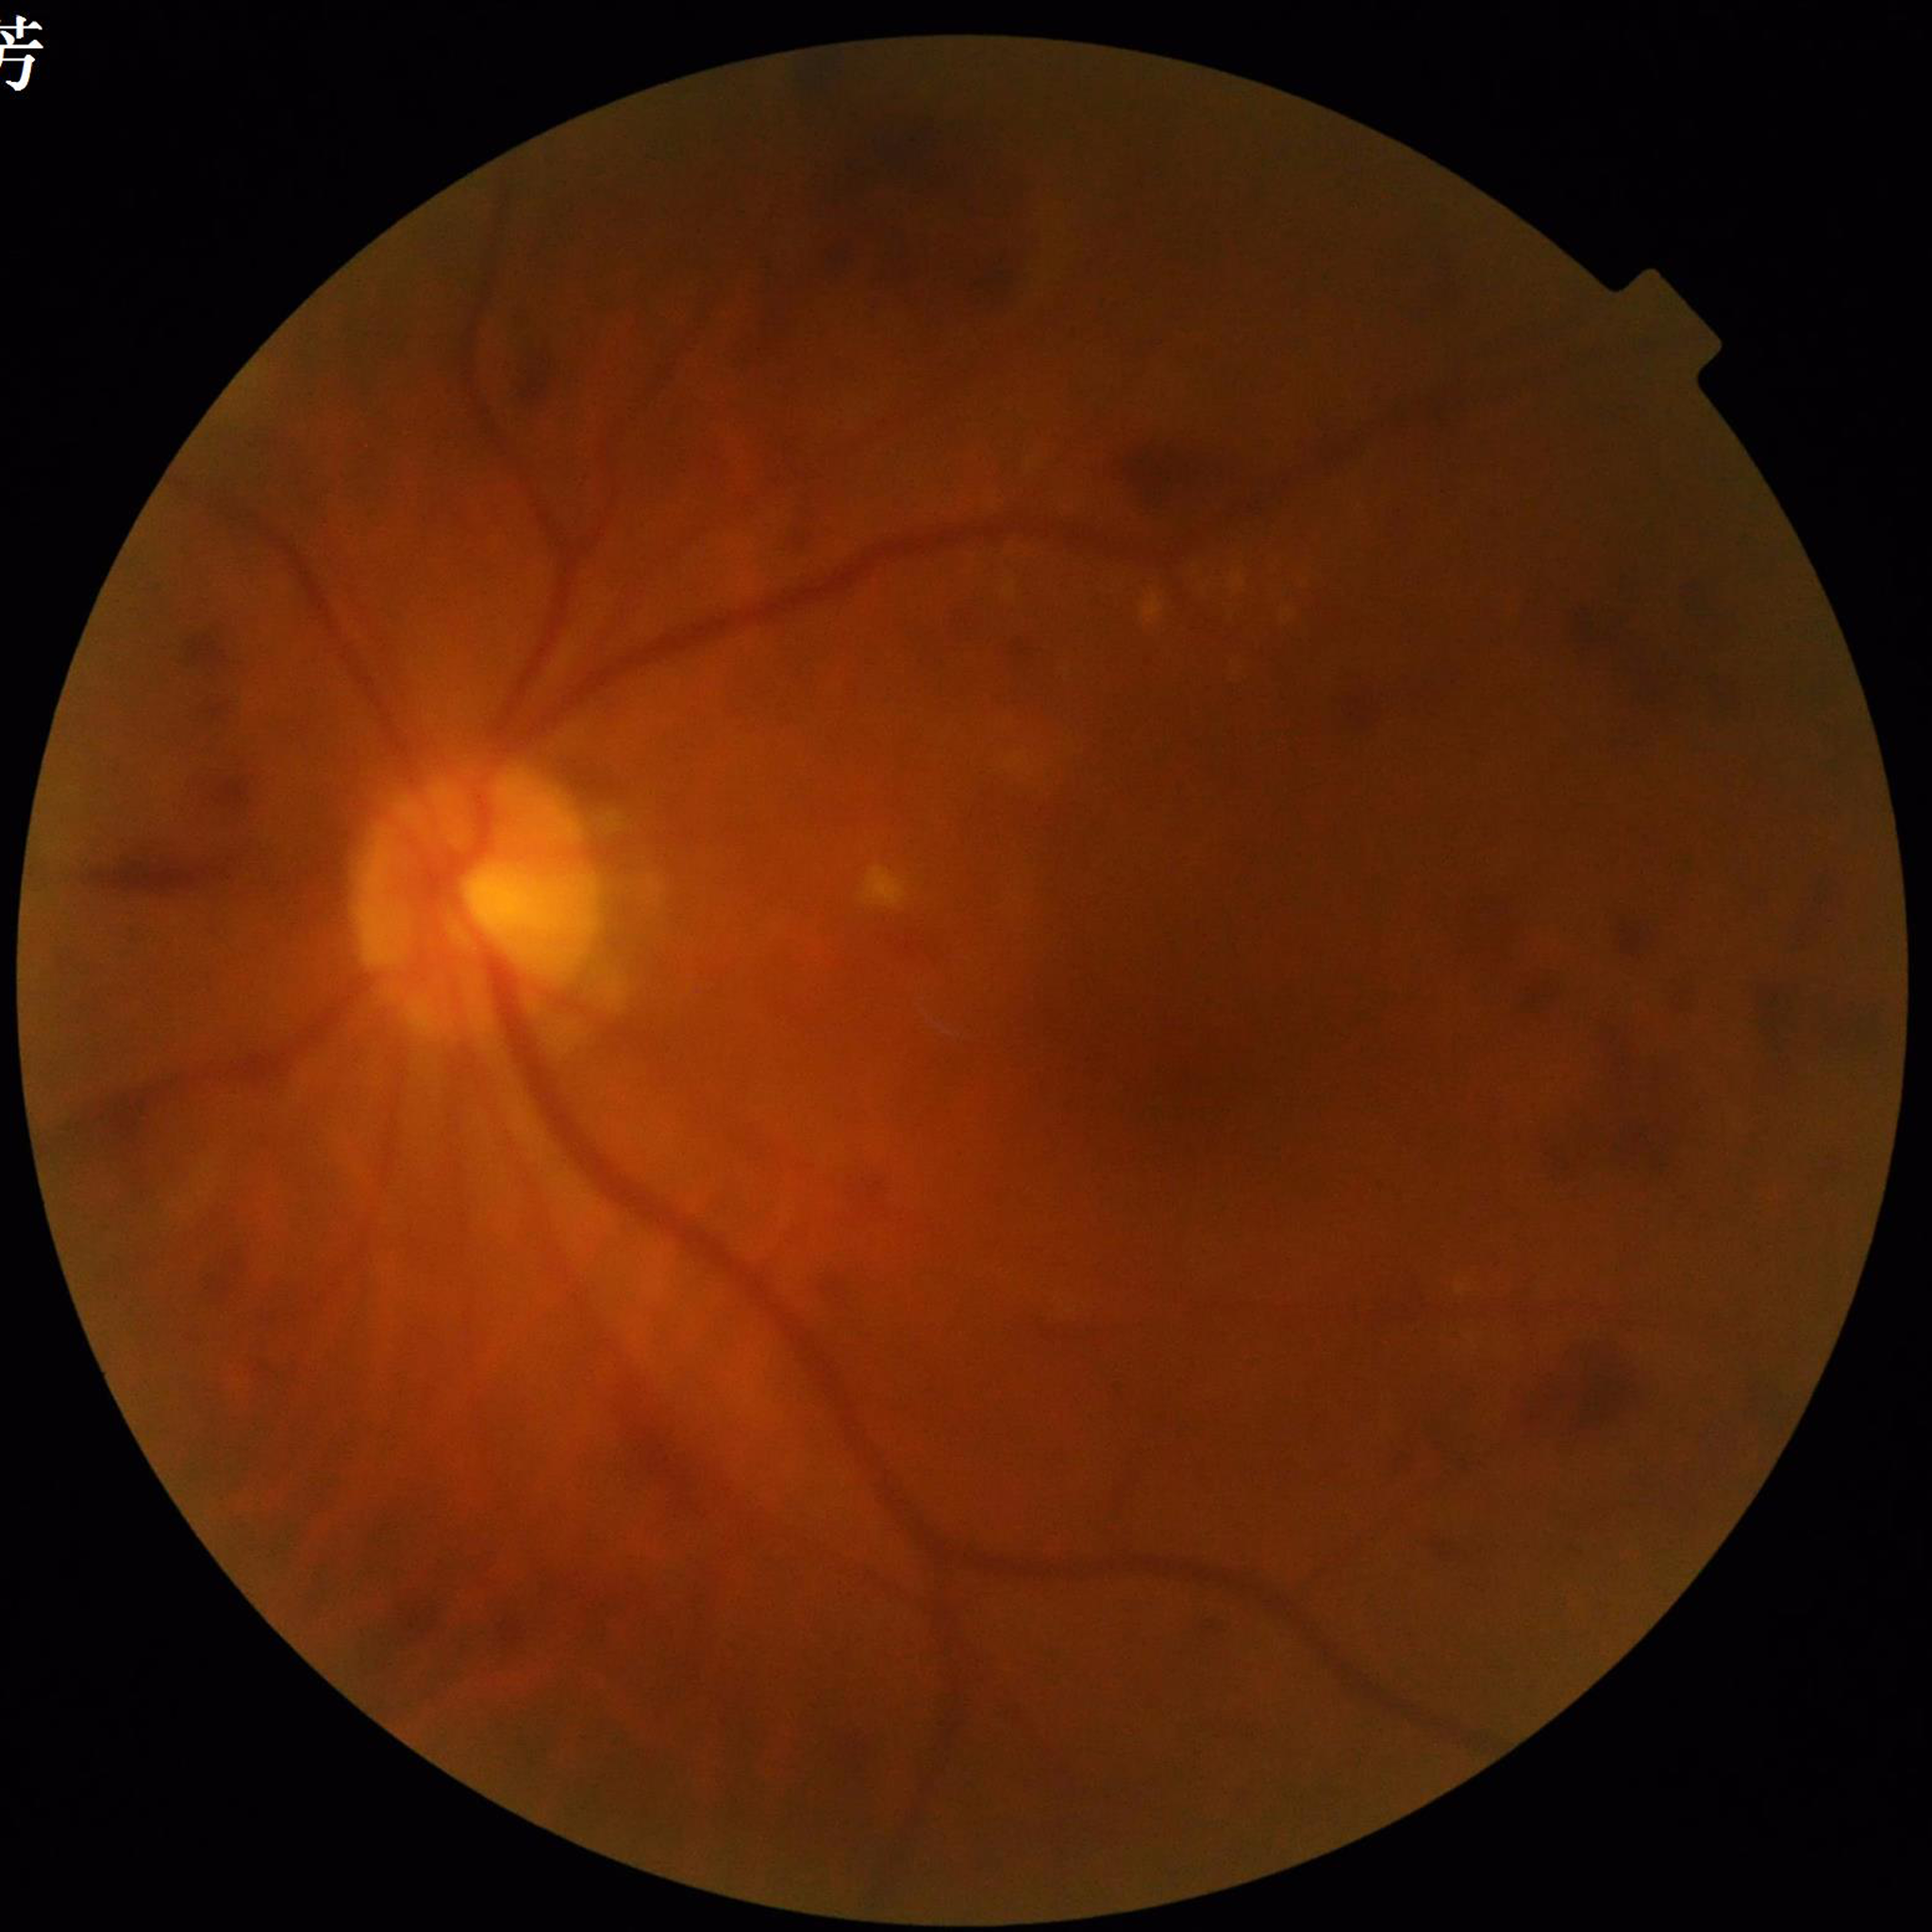
Photo quality = contrast adequate, blur present, illumination and color satisfactory
Impression = DR